Fundus photo; 2048x1536 — 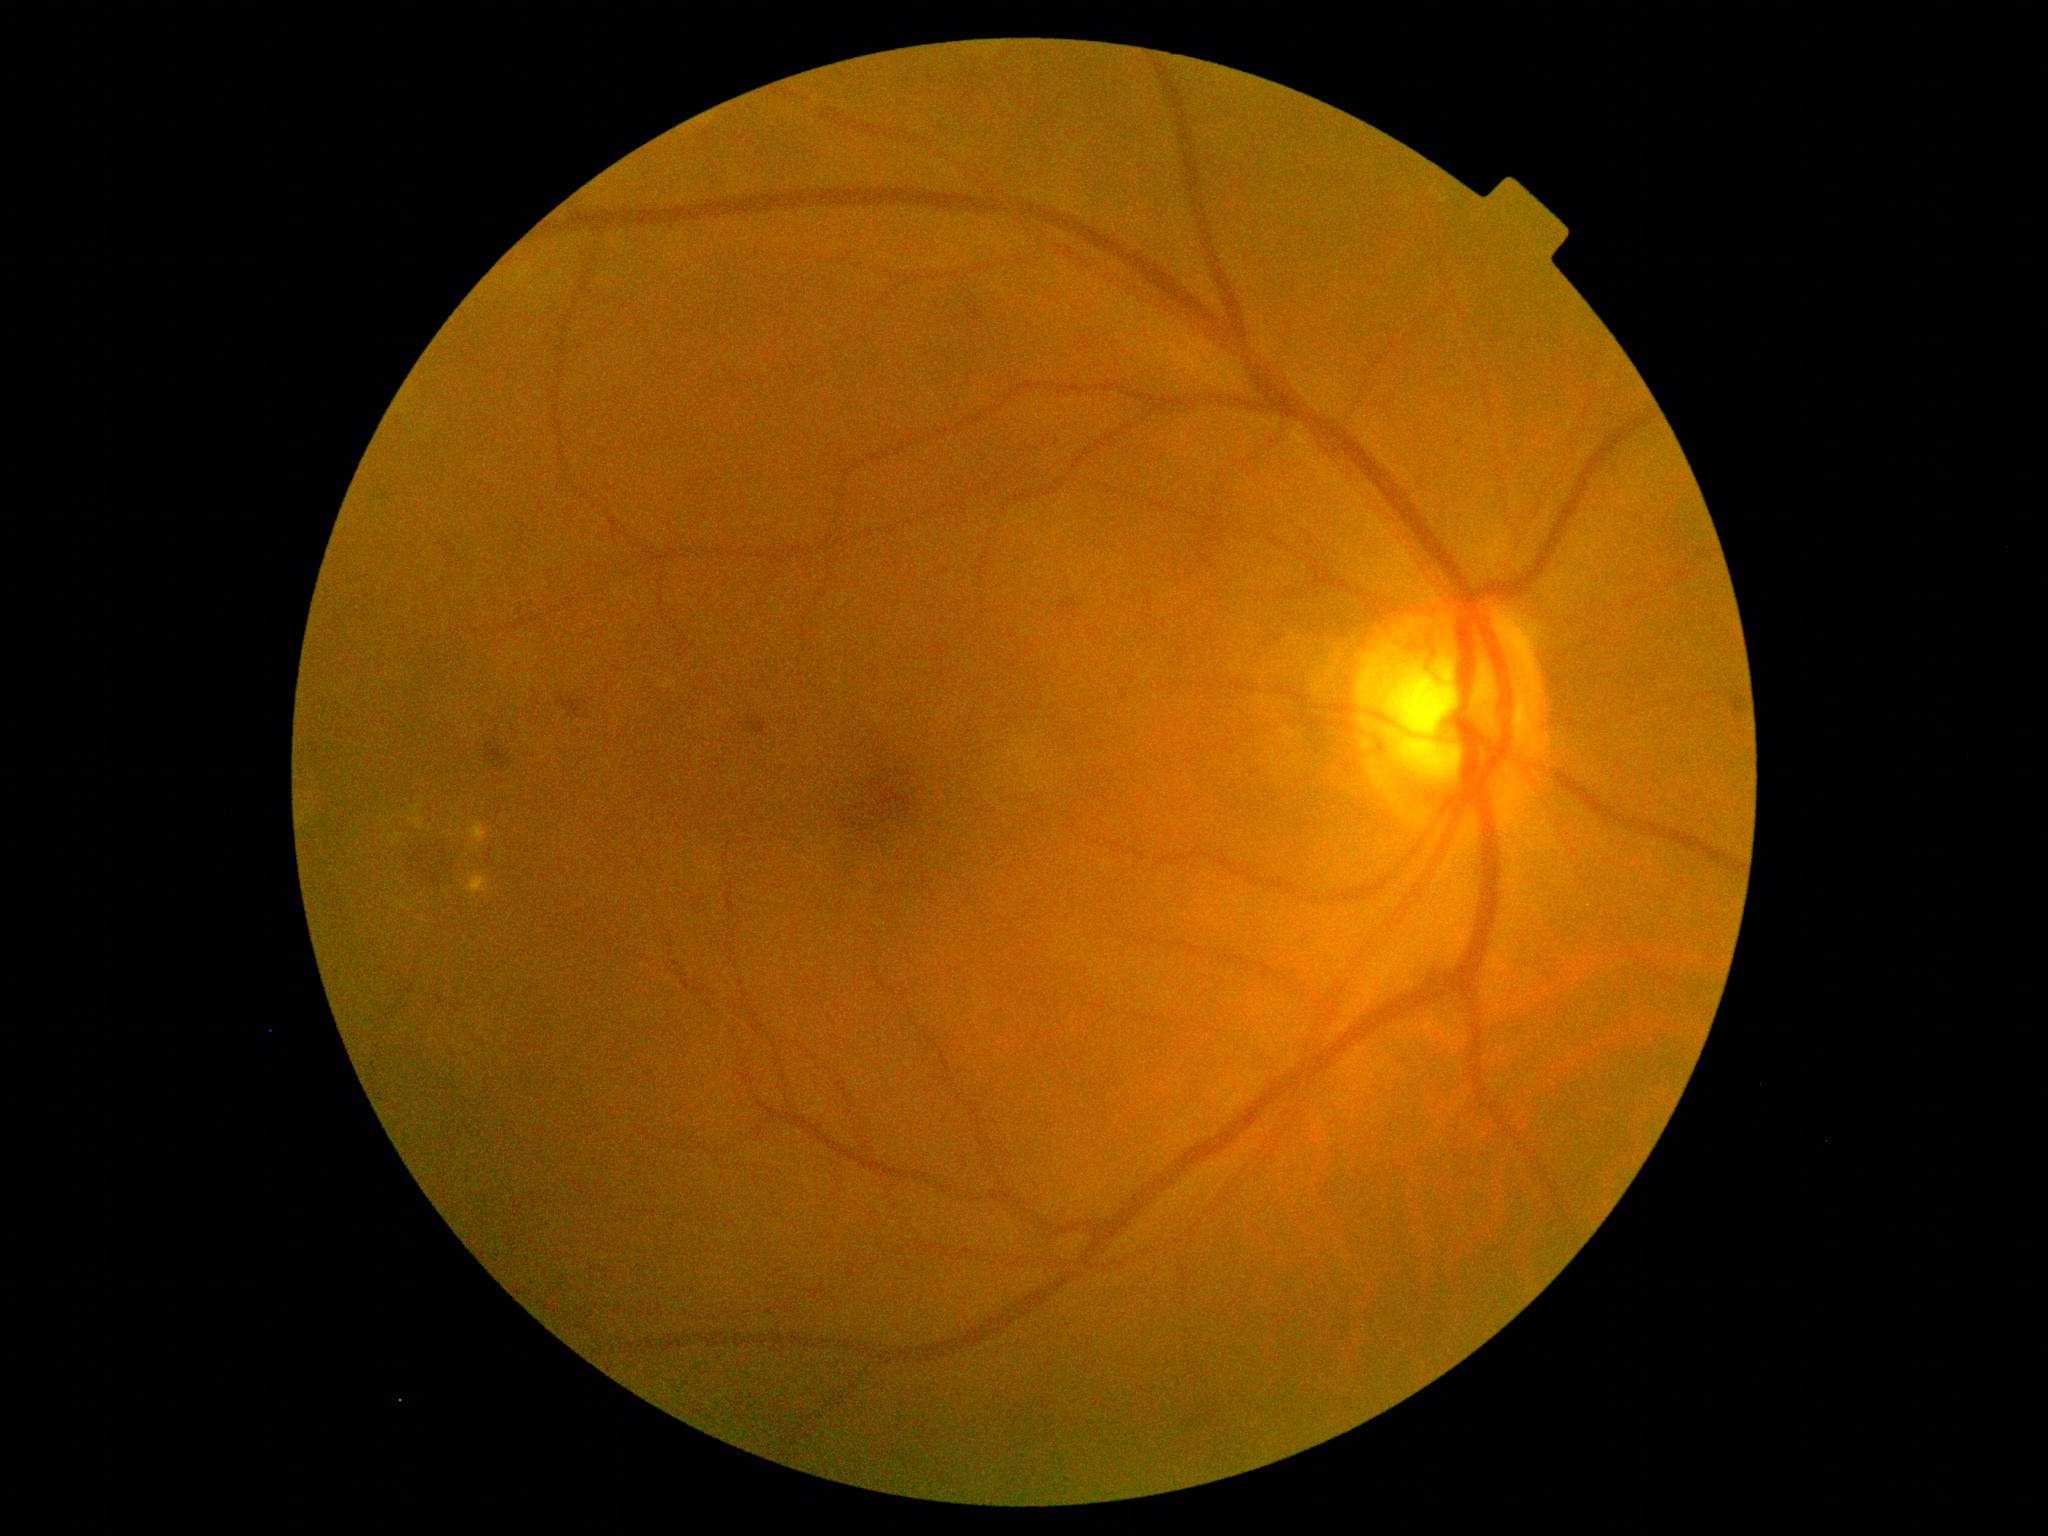

Diabetic retinopathy (DR) is moderate NPDR (grade 2) — more than just microaneurysms but less than severe NPDR.